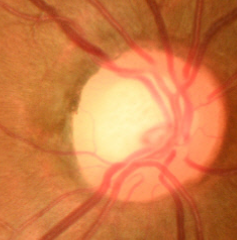
Glaucoma diagnosis: no glaucoma.